Refractive error: sphere +3.5 D, cylinder -1 D, axis 60°; IOP 17 mmHg by pneumatic tonometry; 2212 x 1661 pixels; 63 years old; fundus photo; axial length (AL) 22.26 mm
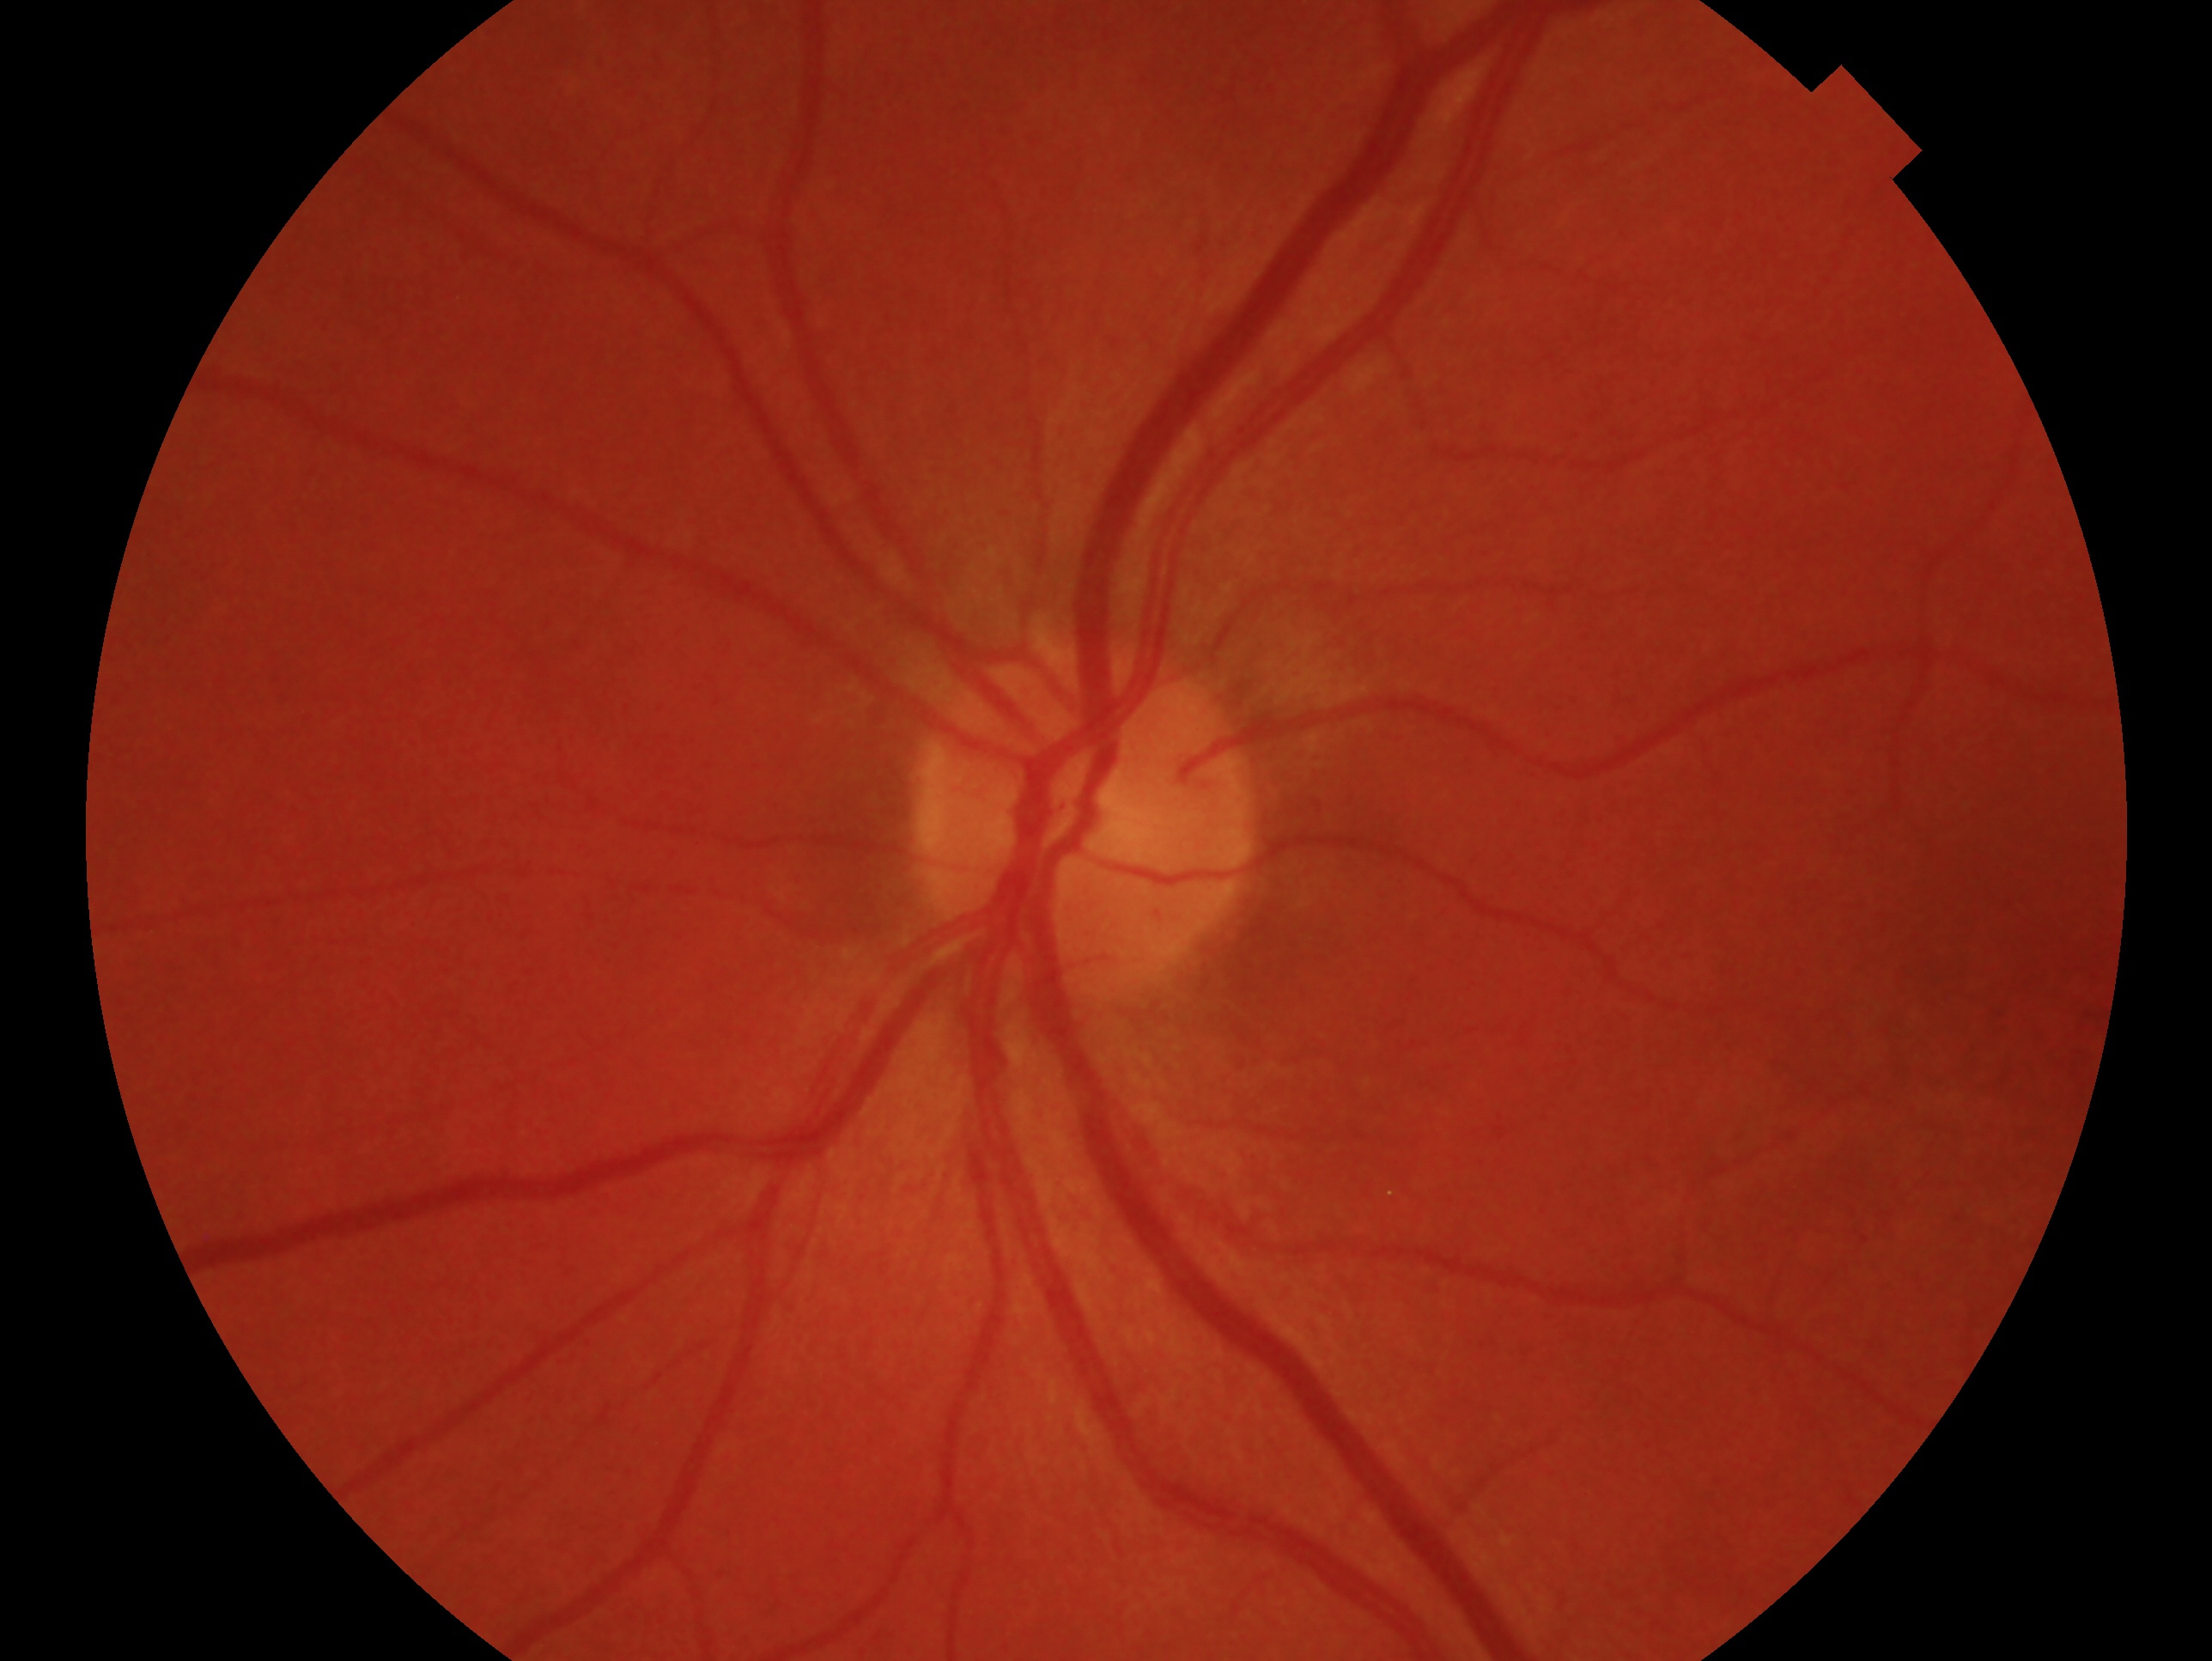 eye: OS; diagnosis: no evidence of glaucoma — no clinical evidence of glaucoma in this eye.